Infant wide-field fundus photograph. 1240 by 1240 pixels. 100° field of view (Phoenix ICON)
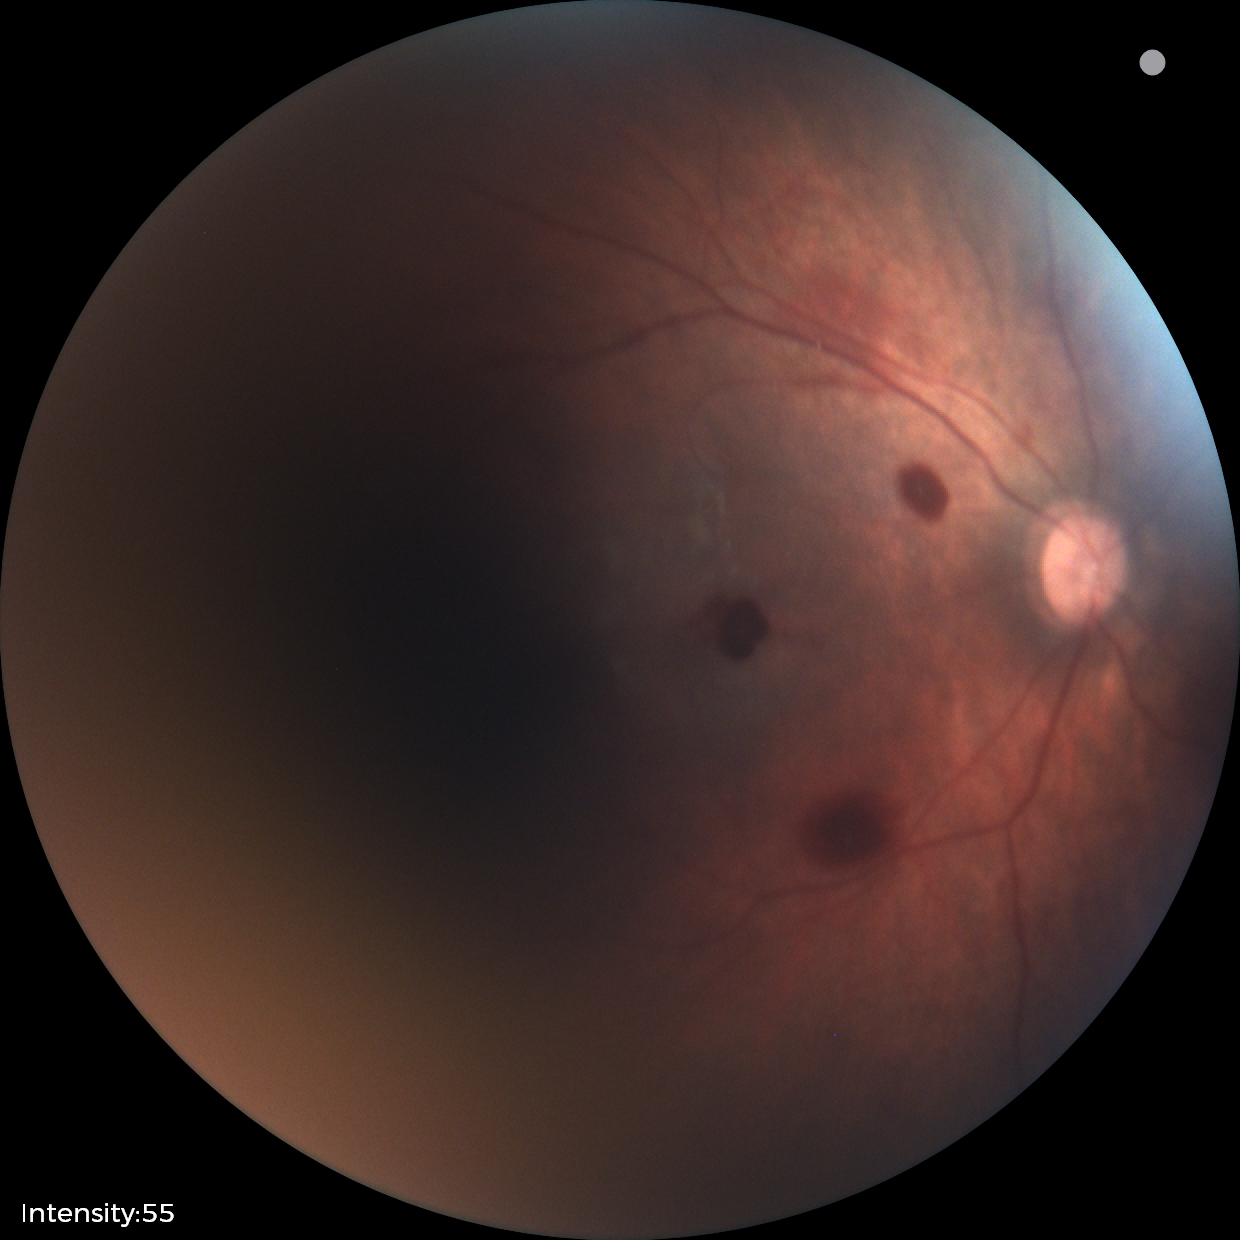 Diagnosis from this screening exam: retinal hemorrhages.